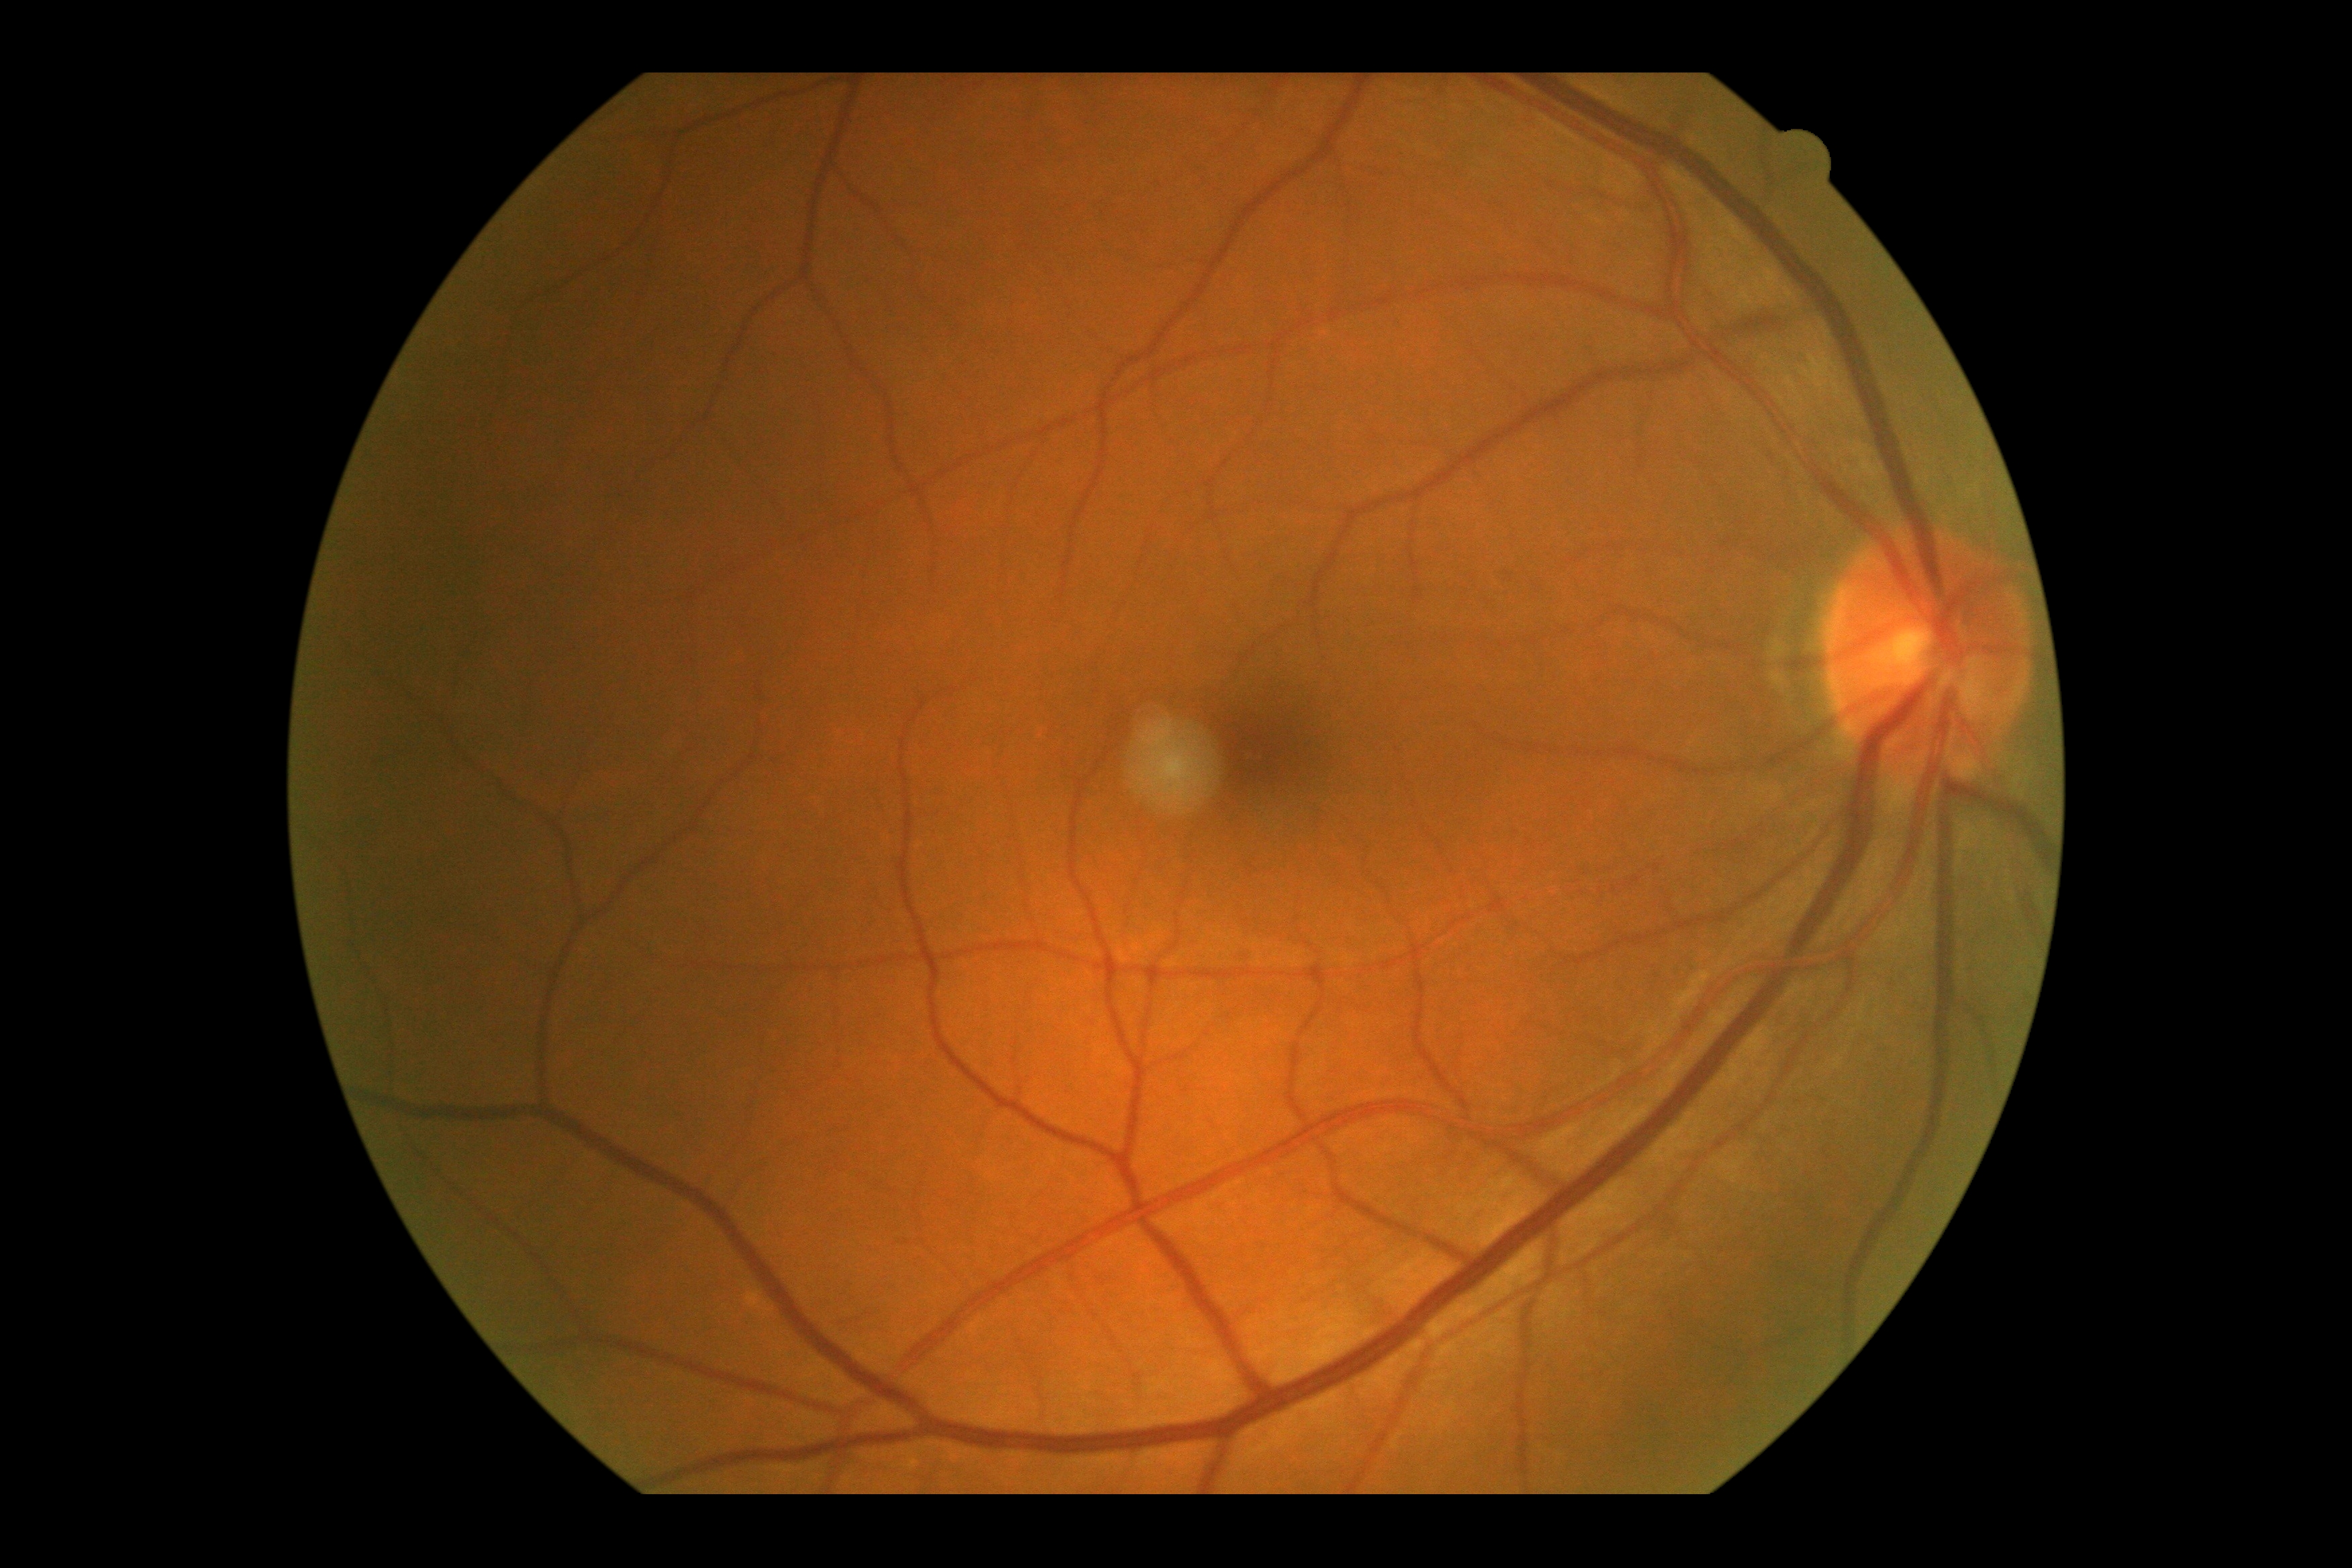
{"dr_grade": "0 — no visible signs of diabetic retinopathy", "dr_impression": "no signs of DR"}